1380 by 1382 pixels · CFP · FOV: 45 degrees
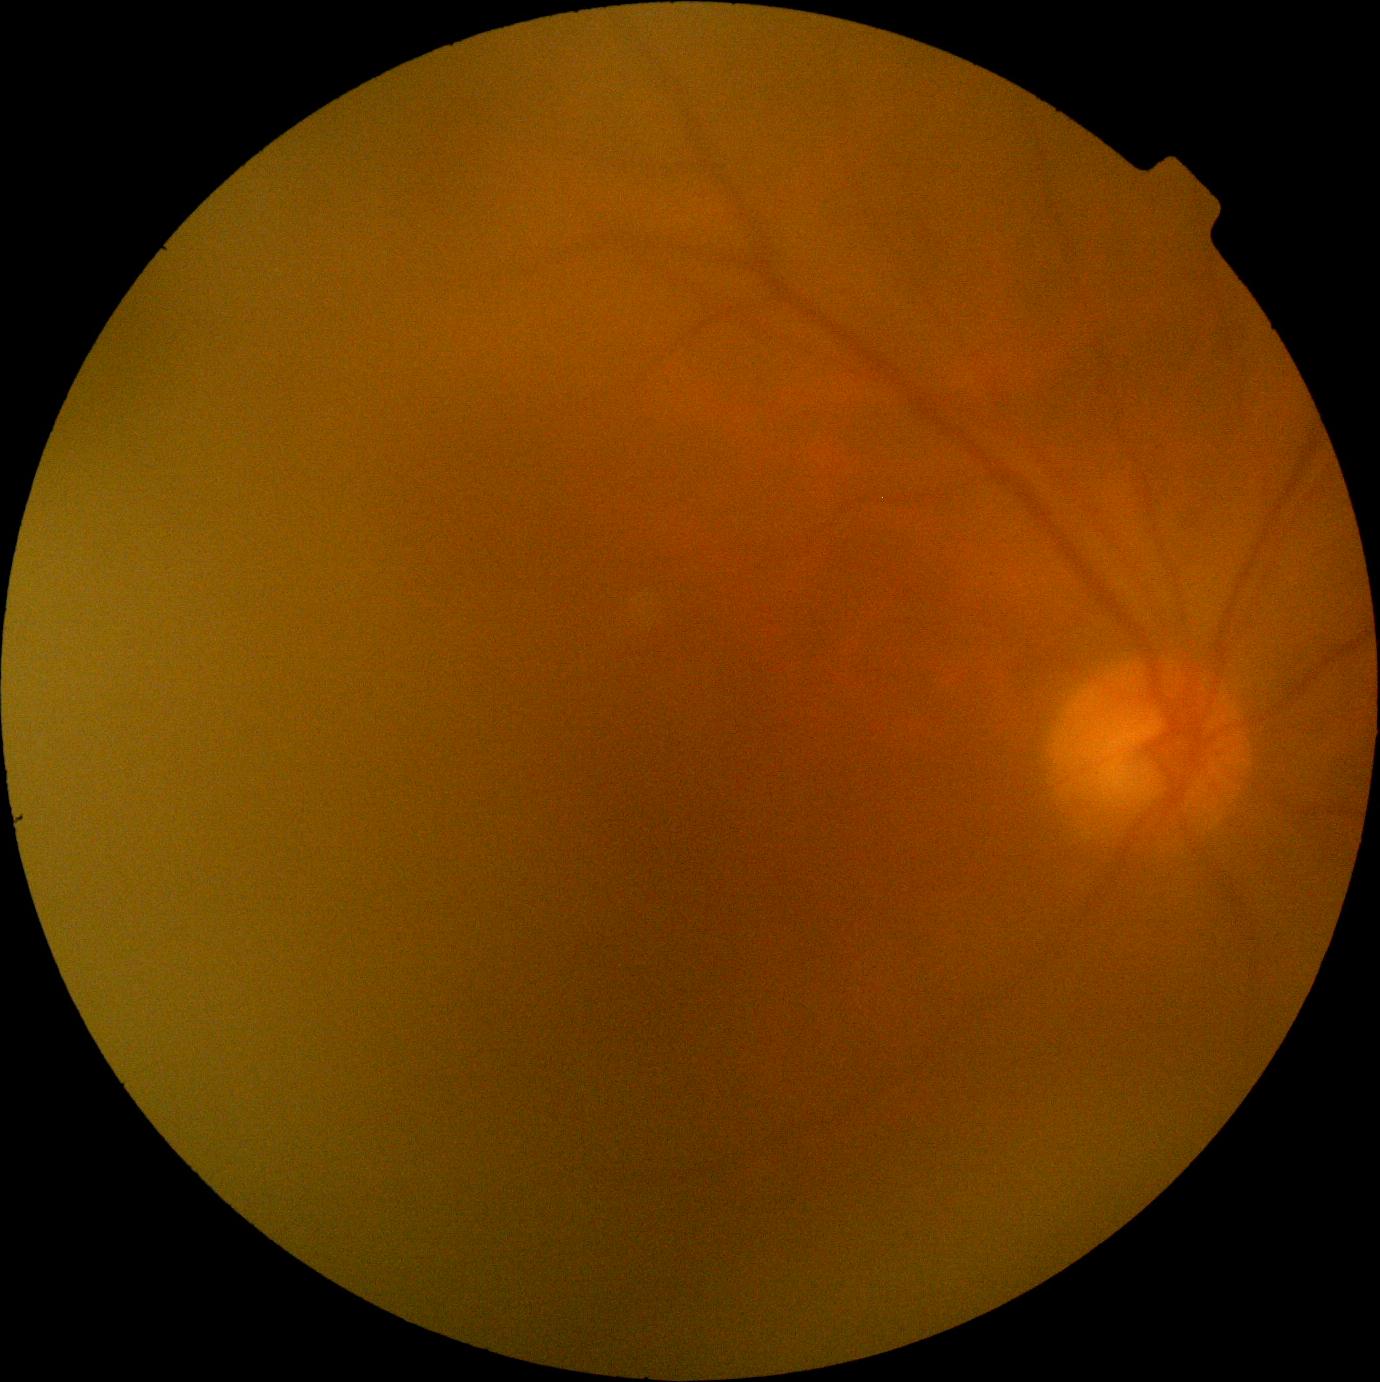

DR stage is 0/4 — no visible signs of diabetic retinopathy.